Natus RetCam Envision, 130° FOV · RetCam wide-field infant fundus image
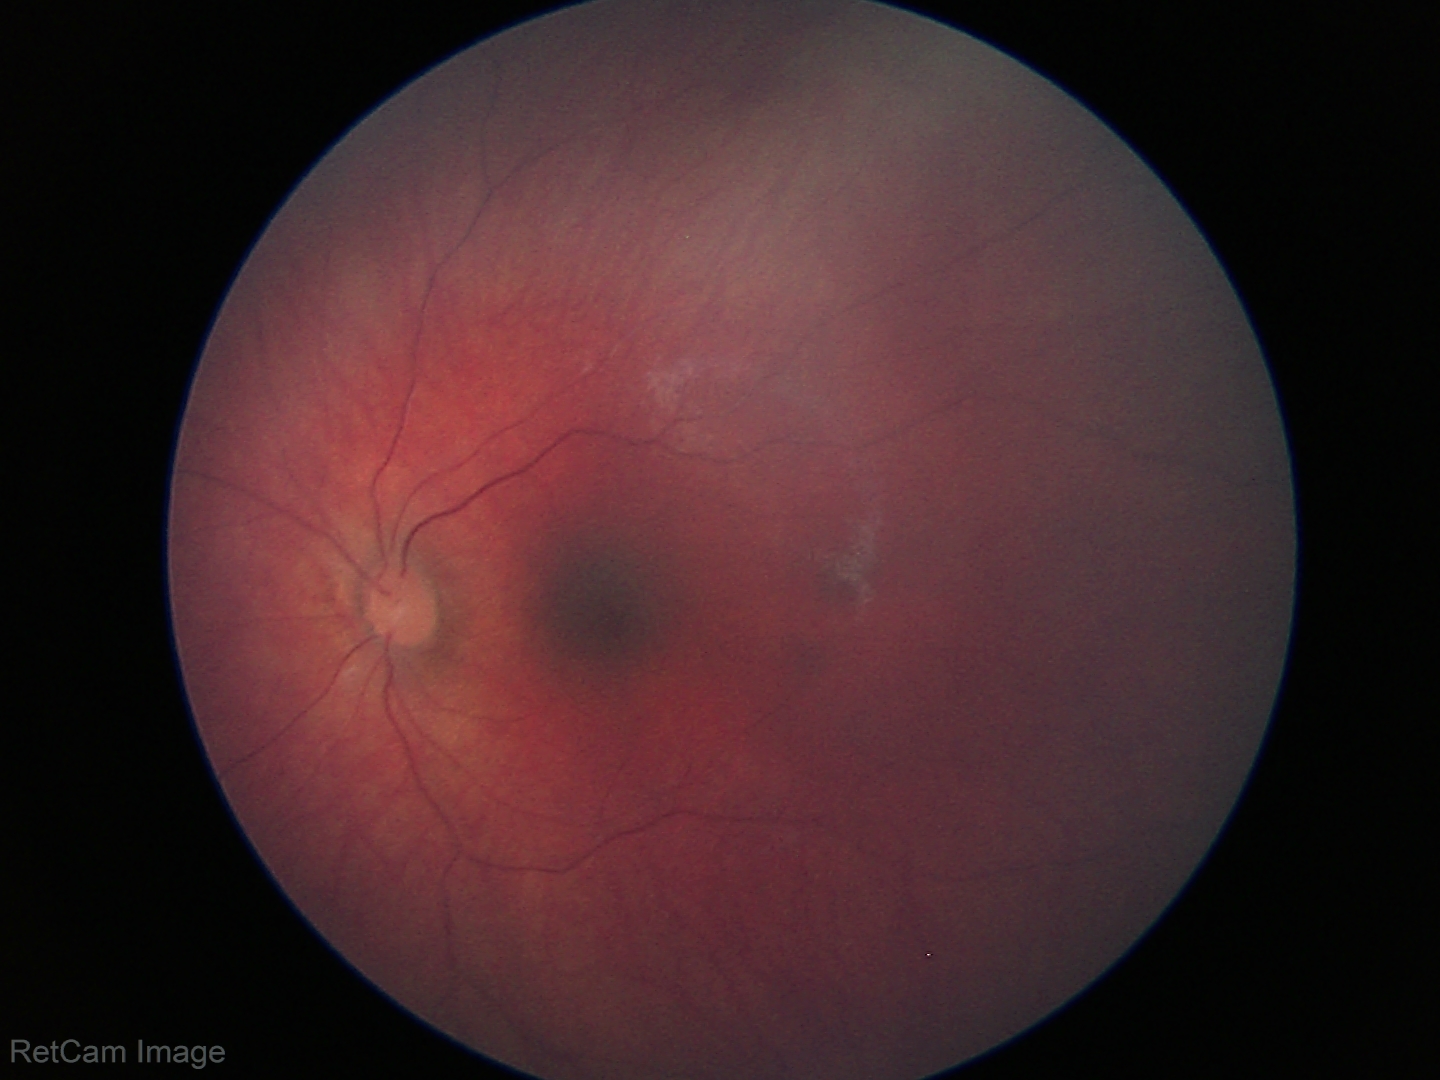 No retinal pathology identified on screening.